Pediatric retinal photograph (wide-field): 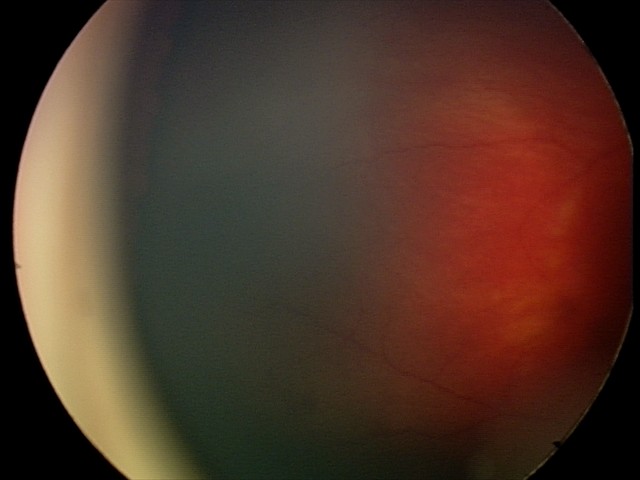 Impression: retinal hemorrhages.